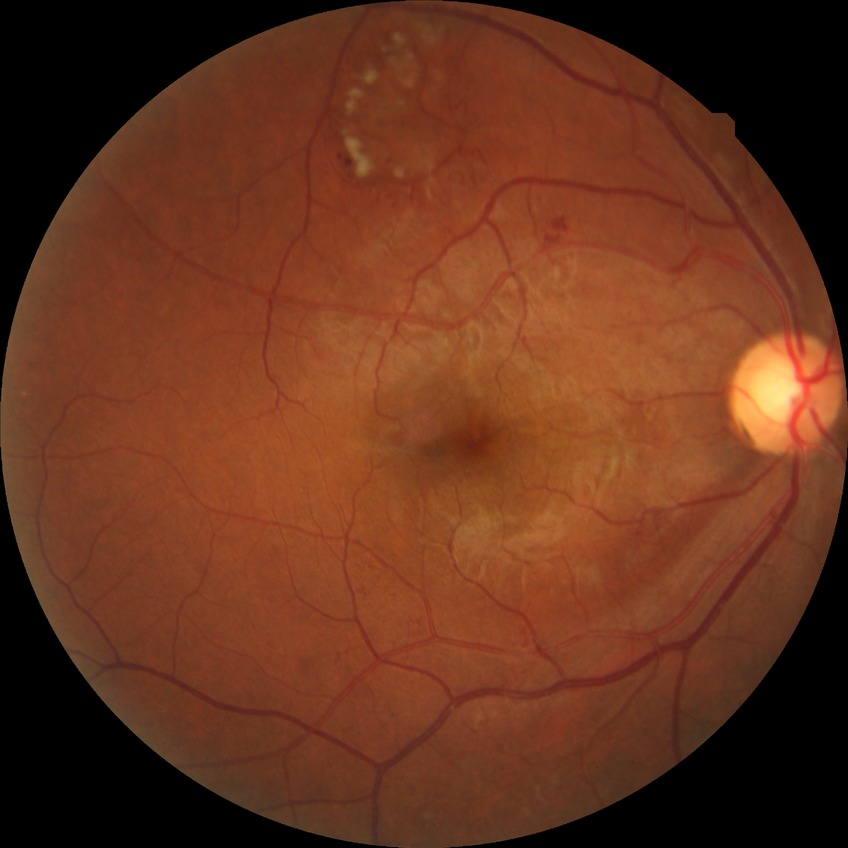 diabetic retinopathy (DR): PPDR (pre-proliferative diabetic retinopathy)
DR class: non-proliferative diabetic retinopathy